NIDEK AFC-230 fundus camera; color fundus photograph; without pupil dilation
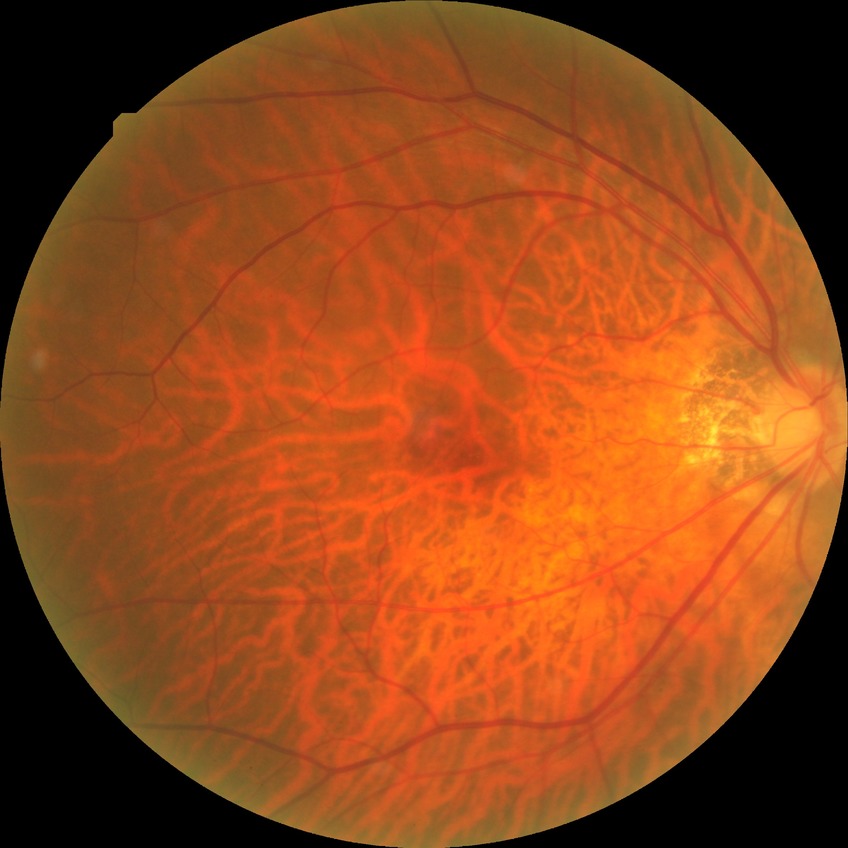
Diabetic retinopathy (DR): no diabetic retinopathy (NDR).